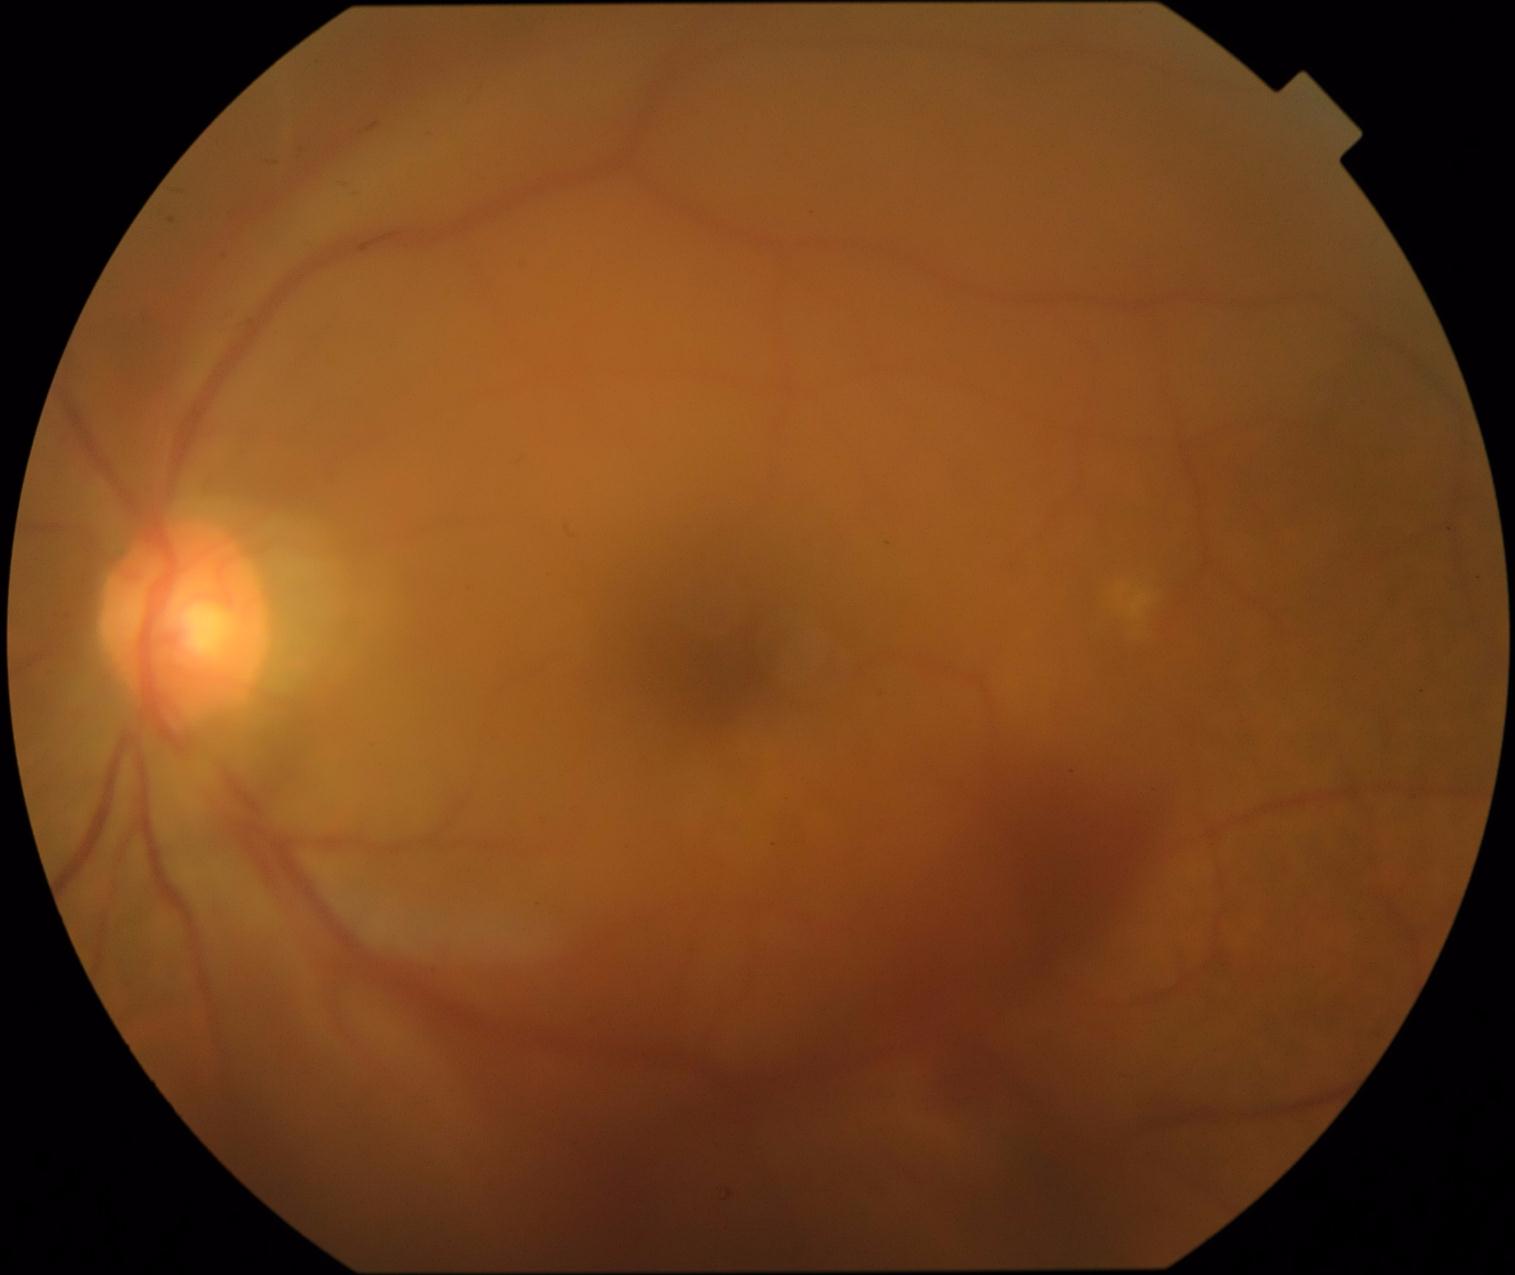
{"dr_grade": "proliferative diabetic retinopathy (grade 4)"}